2346 by 1568 pixels
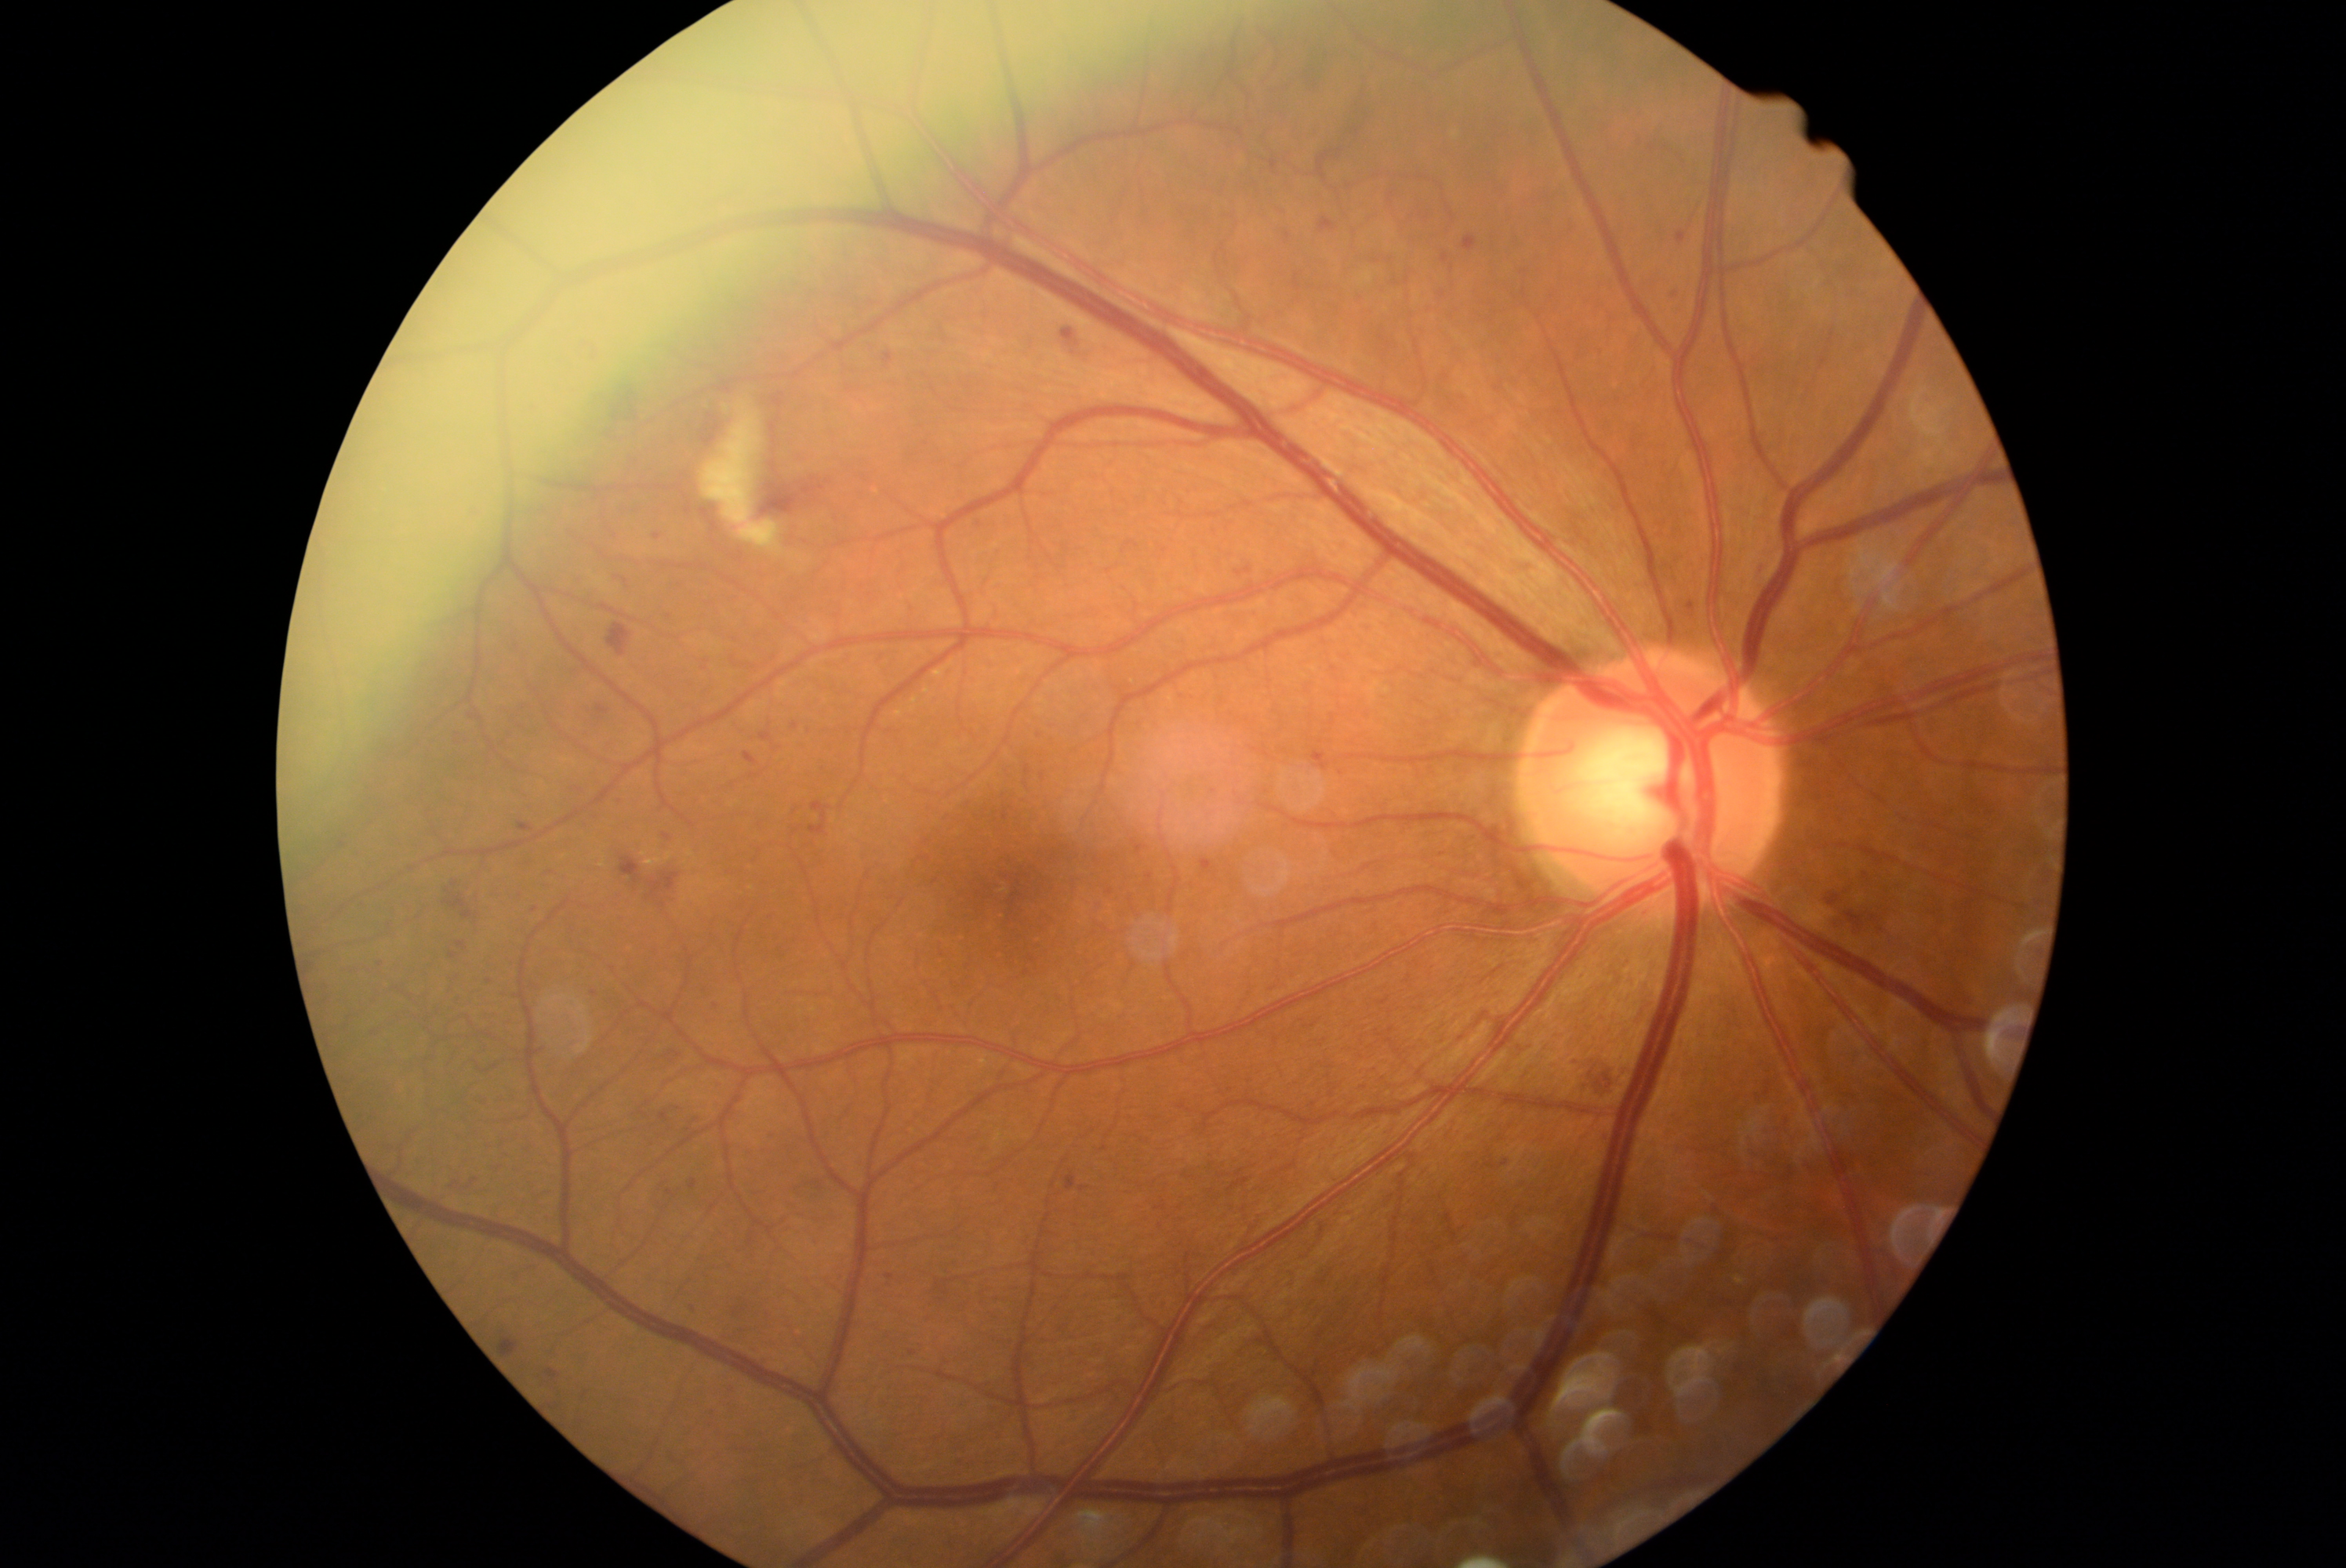

dr_grade: moderate non-proliferative diabetic retinopathy (2)